2212x1659px, CFP: 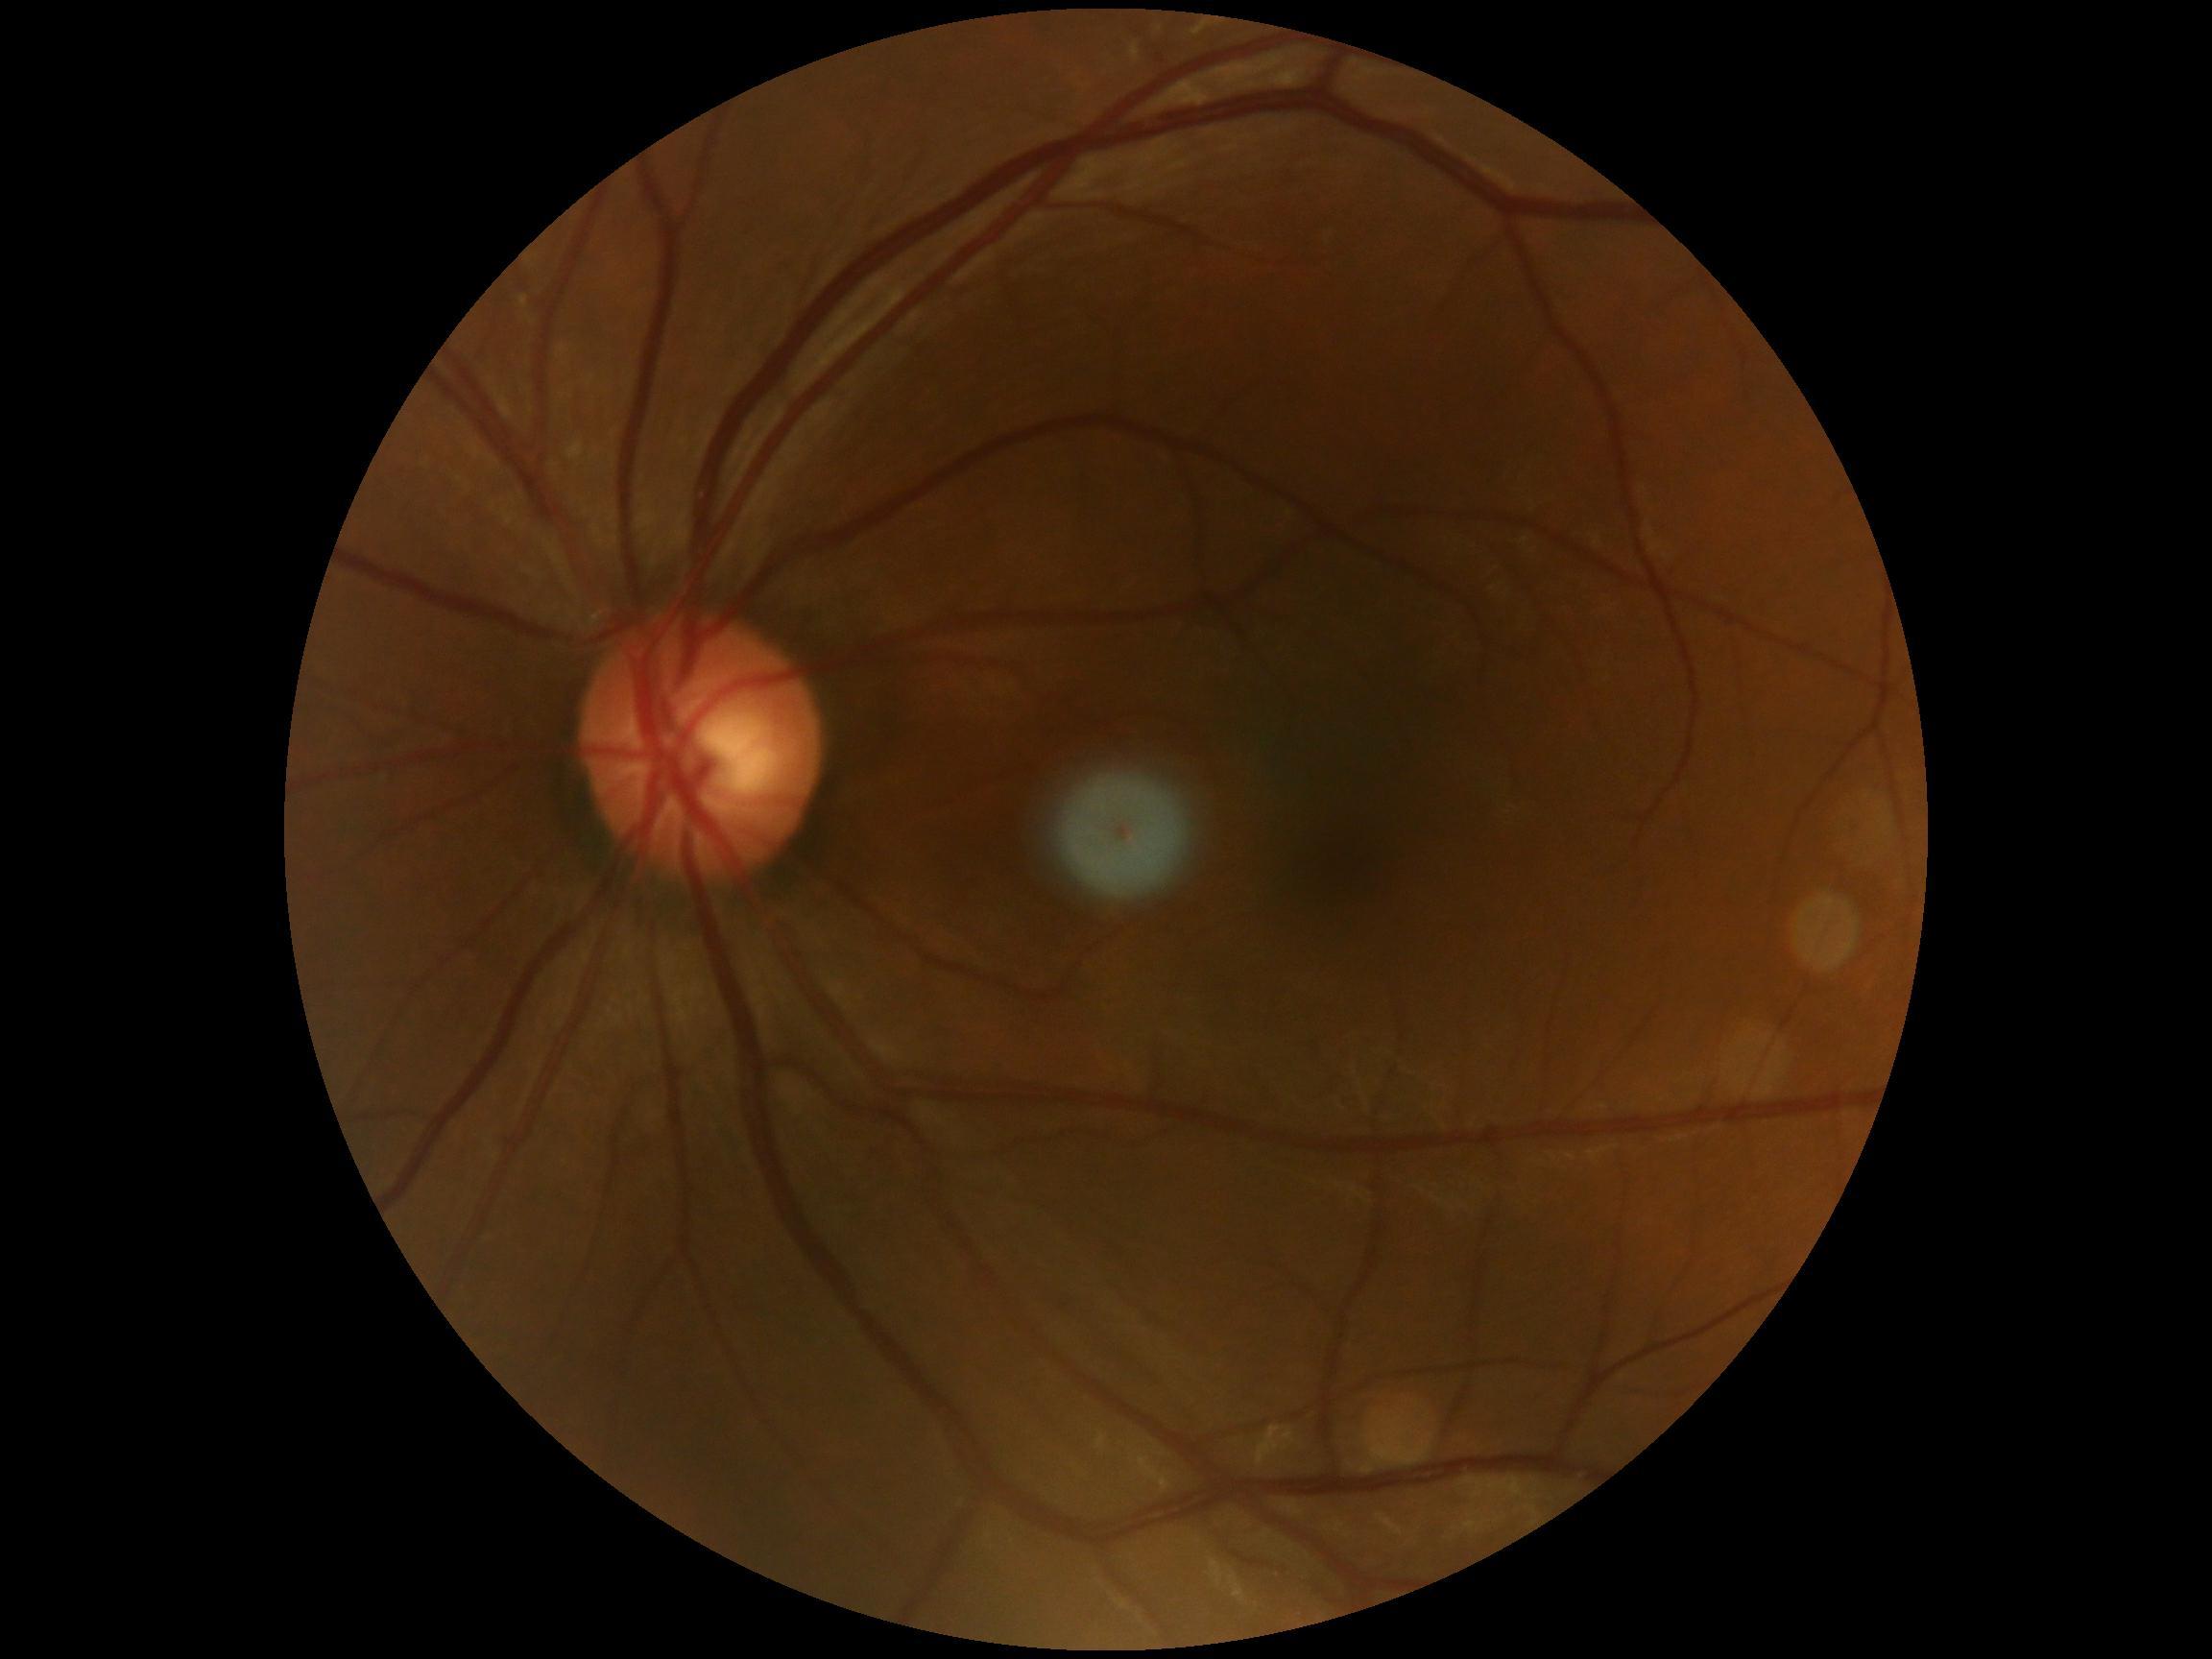

No apparent diabetic retinopathy. Diabetic retinopathy grade: no apparent retinopathy (0).